Color fundus photograph — 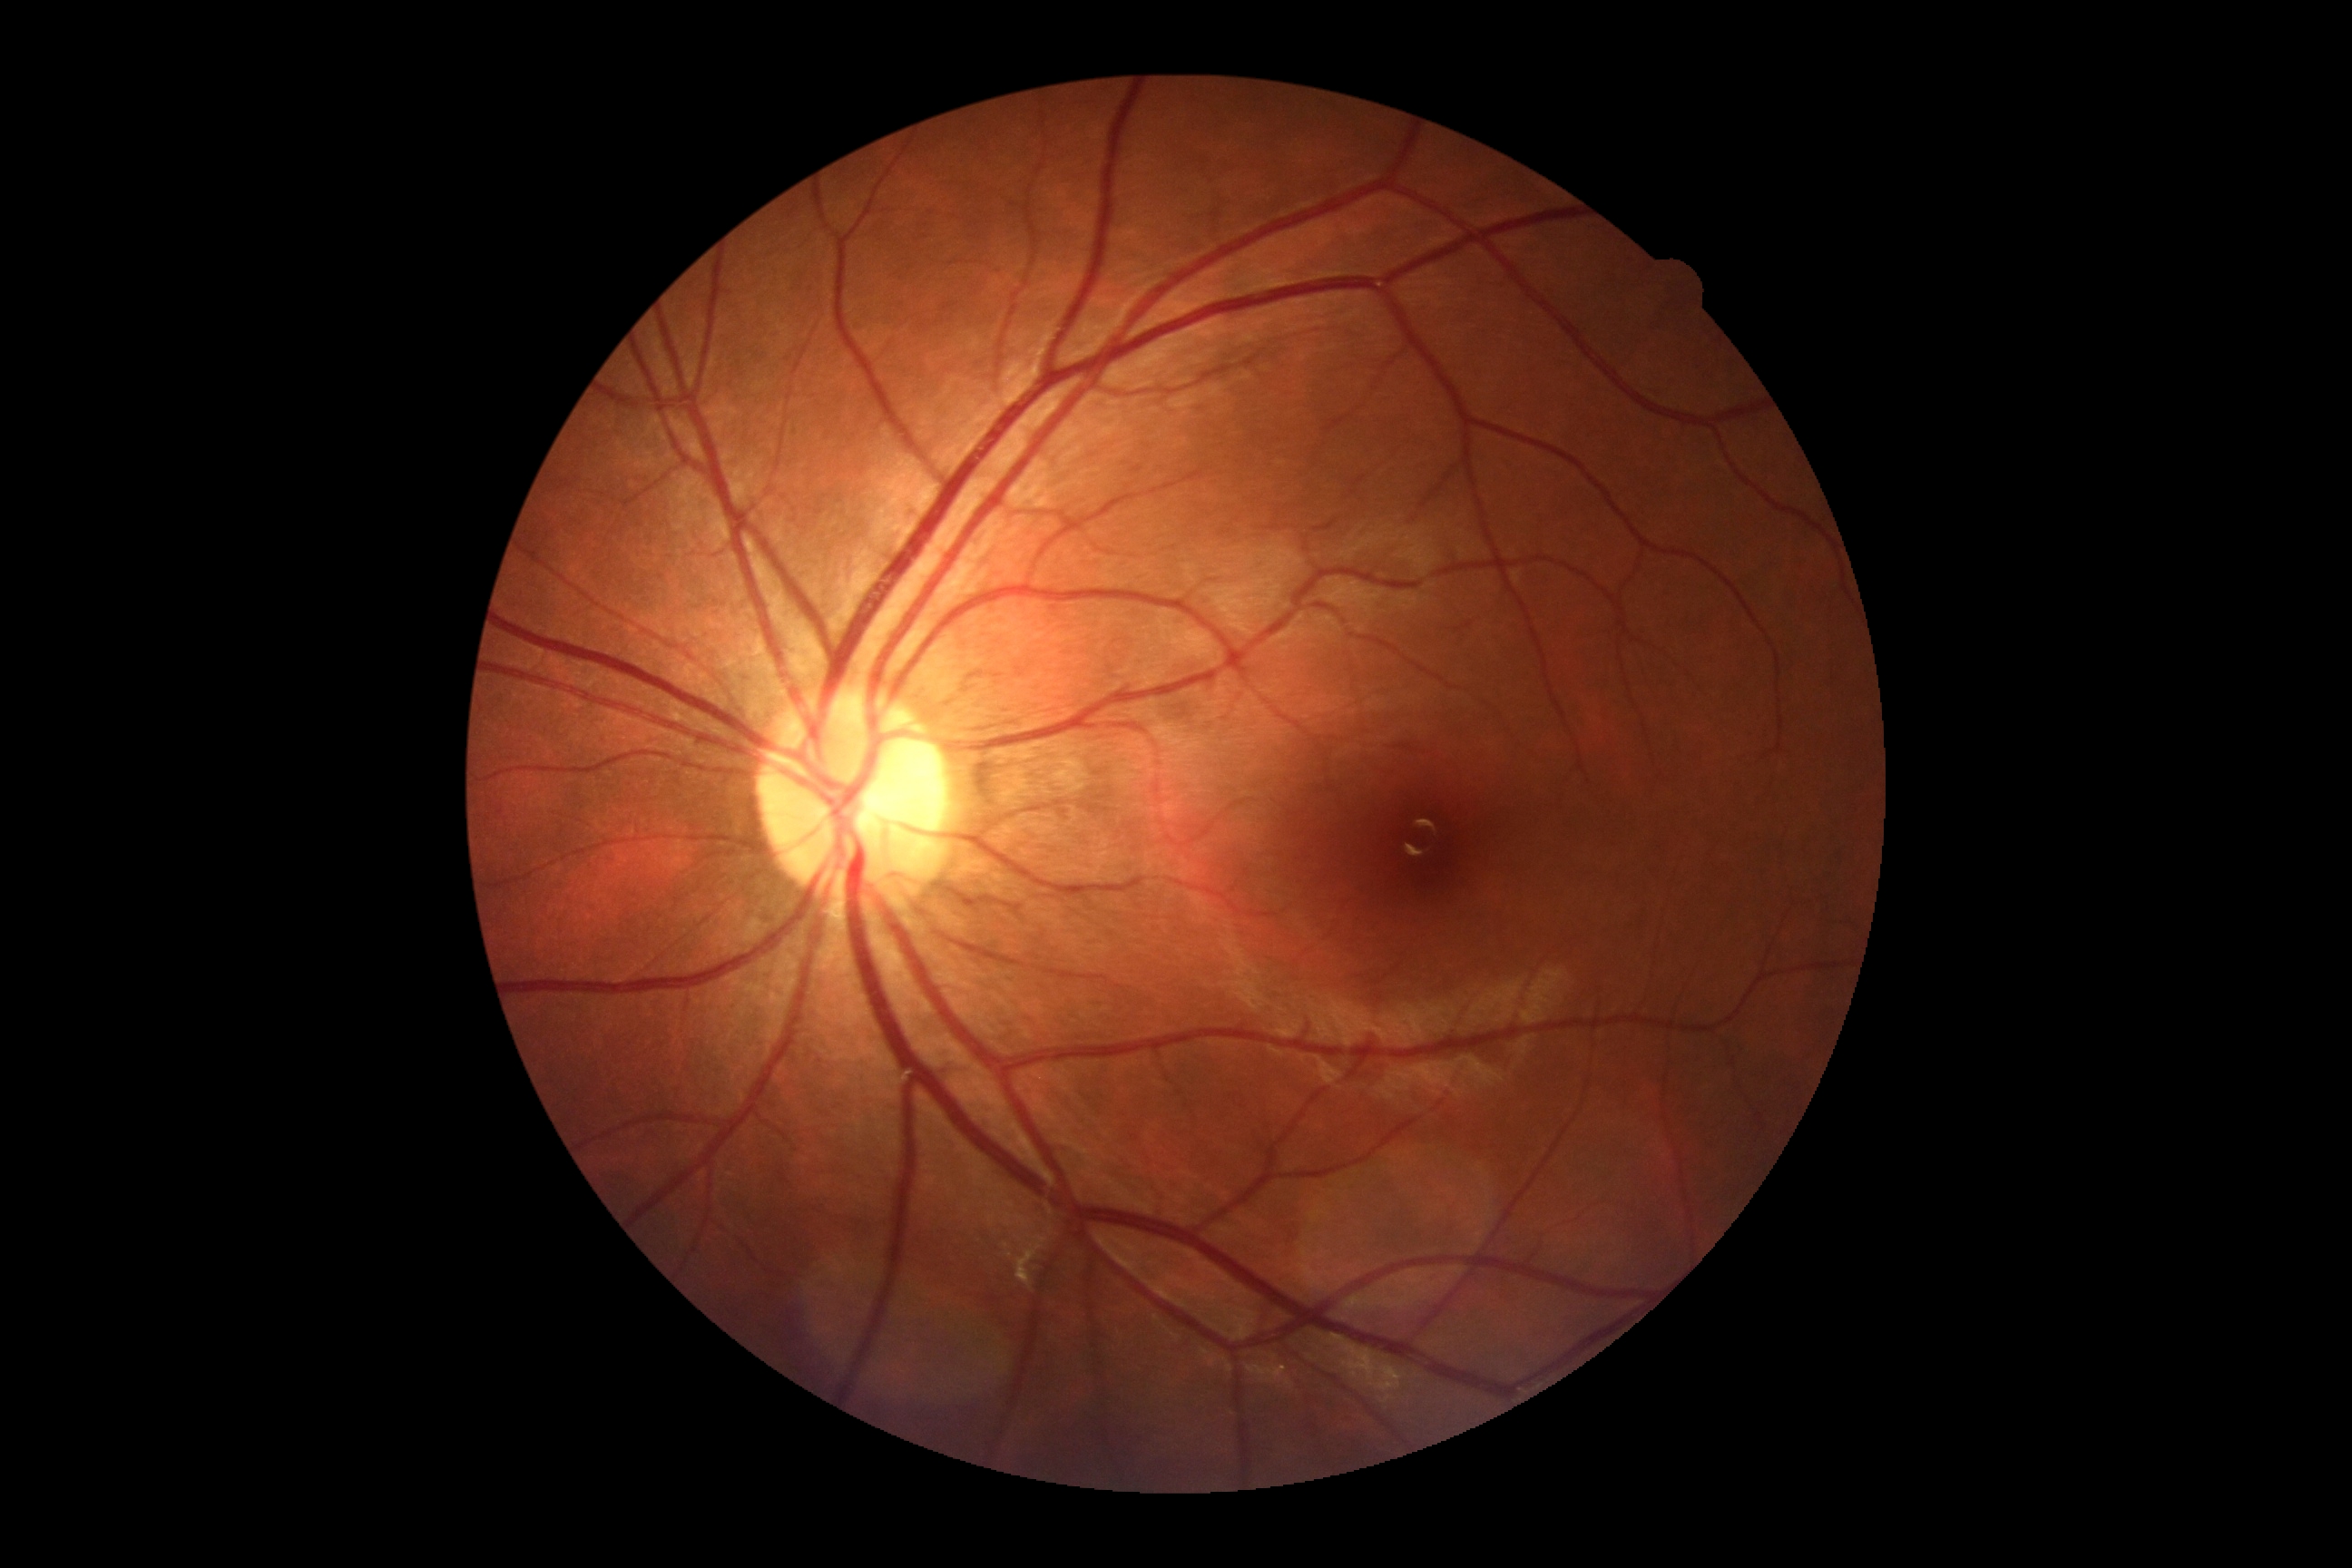

Retinopathy grade is 0.